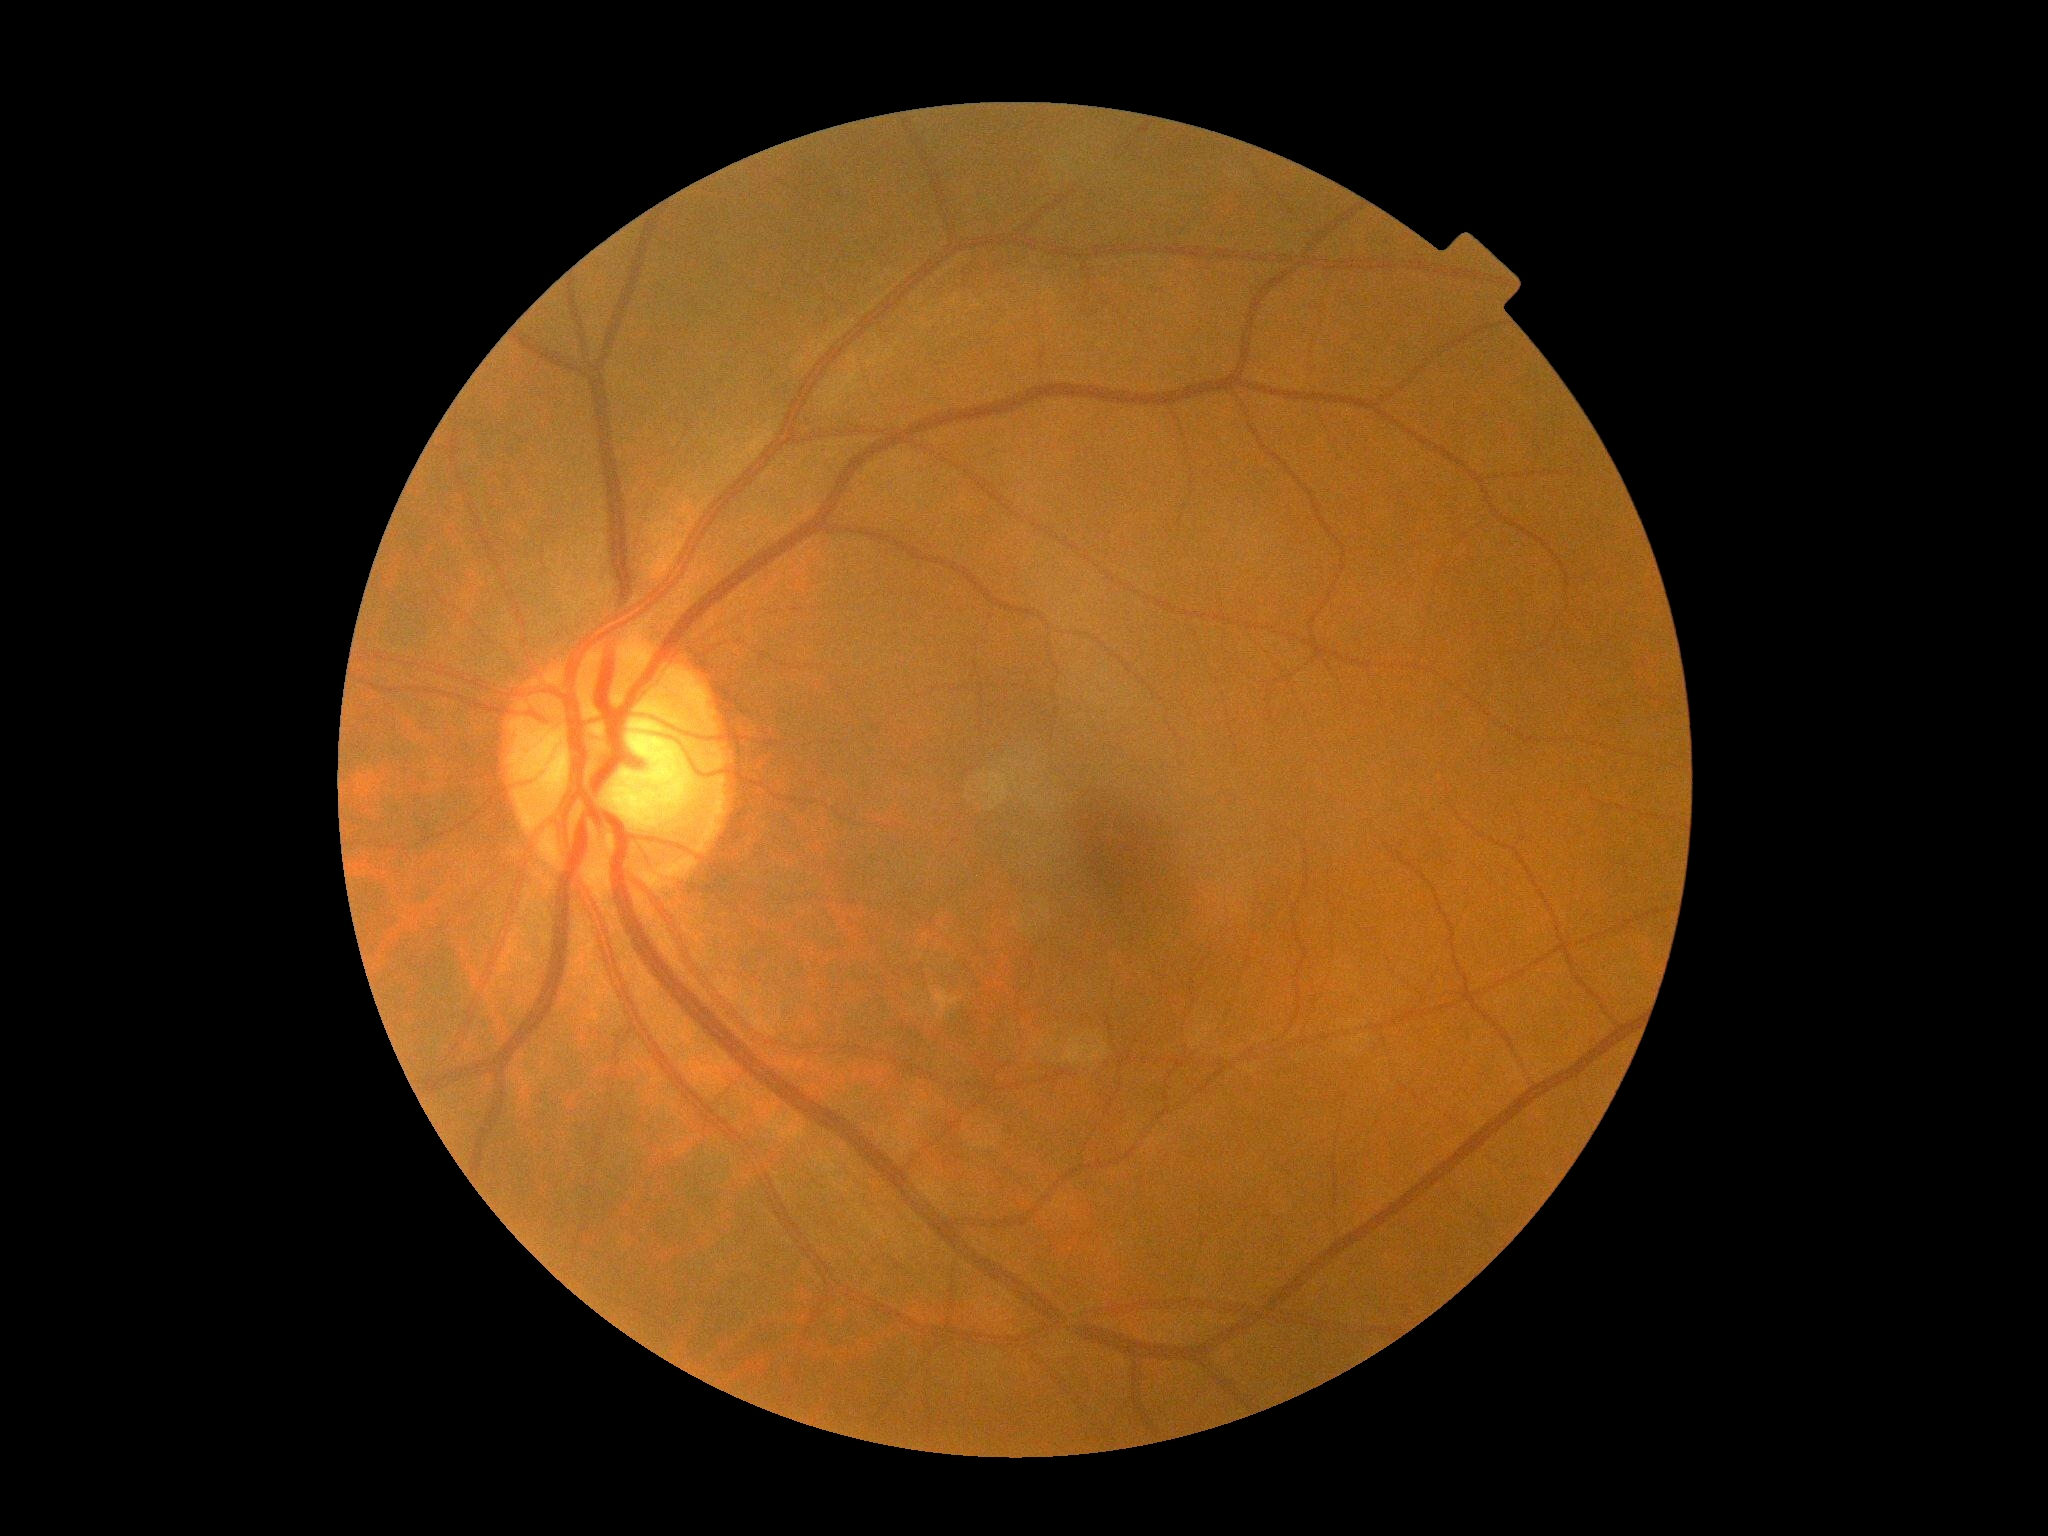

Diabetic retinopathy severity: grade 0 (no apparent retinopathy).